Modified Davis grading
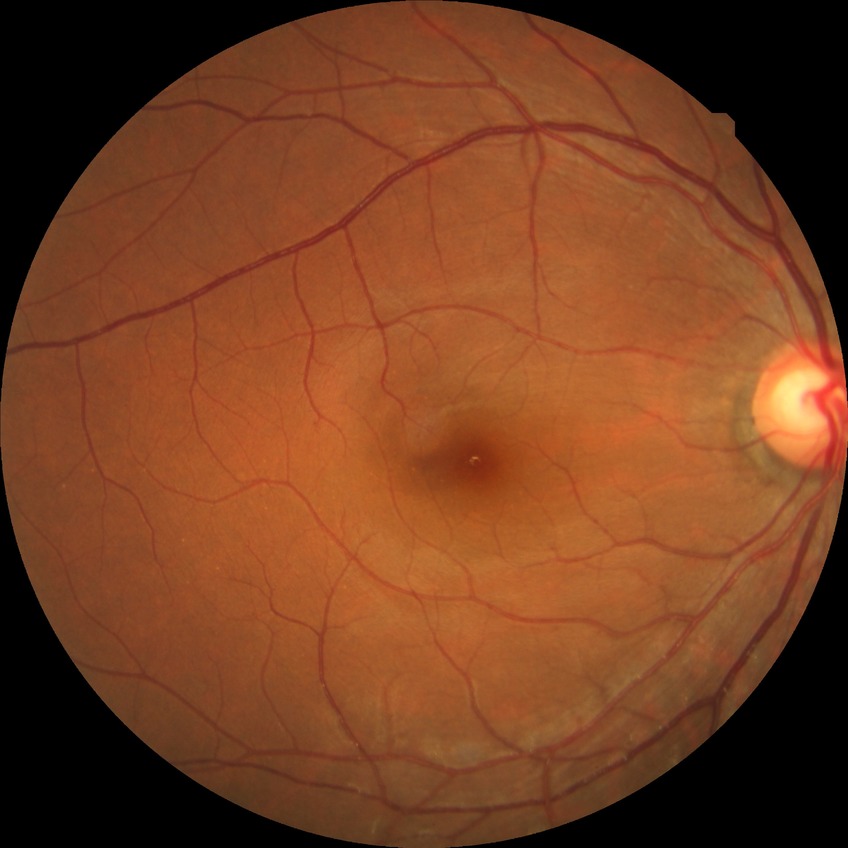
Diabetic retinopathy (DR) is NDR (no diabetic retinopathy).